Camera: Clarity RetCam 3 (130° FOV). 640x480px. Wide-field fundus photograph of an infant: 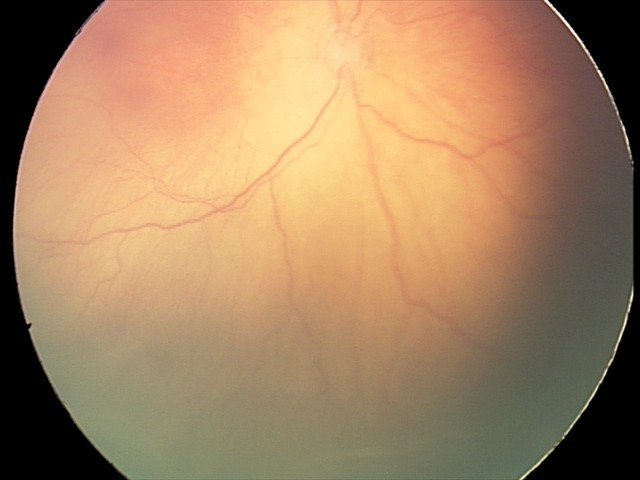 Examination diagnosed as ROP stage 2.